Color fundus photograph. 2352x1568. 45° field of view — 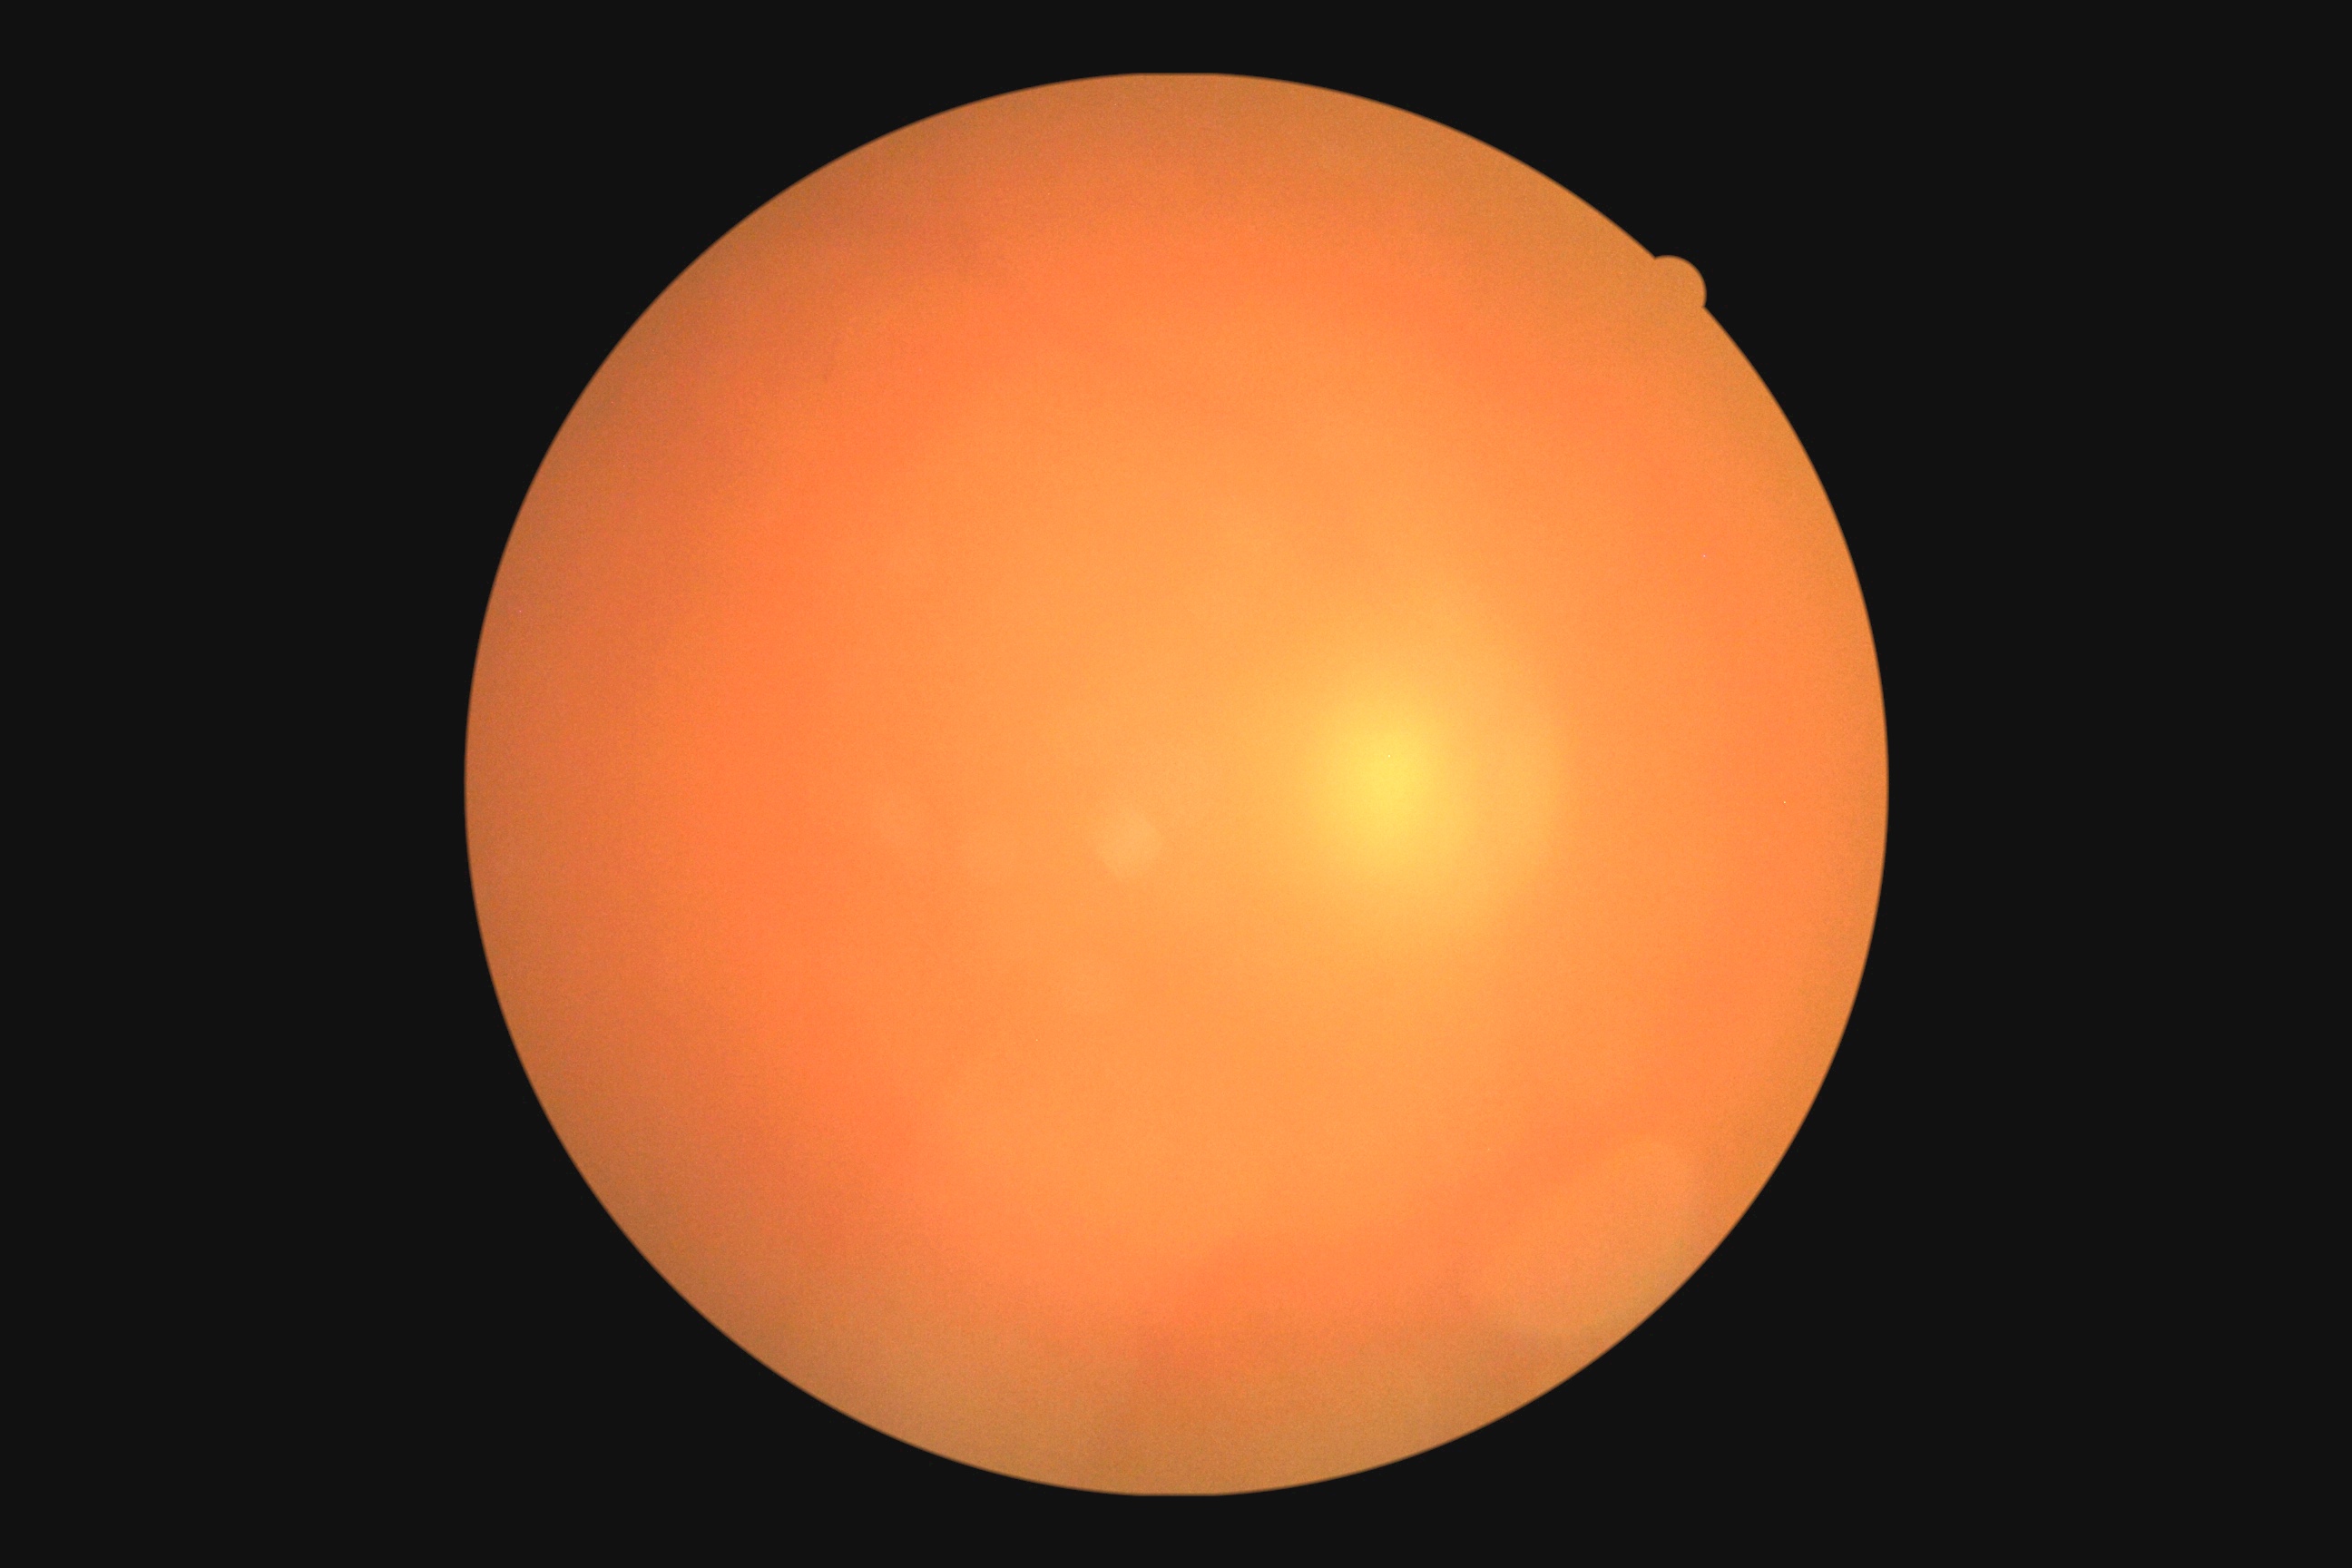 Findings:
- retinopathy: ungradable due to poor image quality
- image quality: below grading threshold